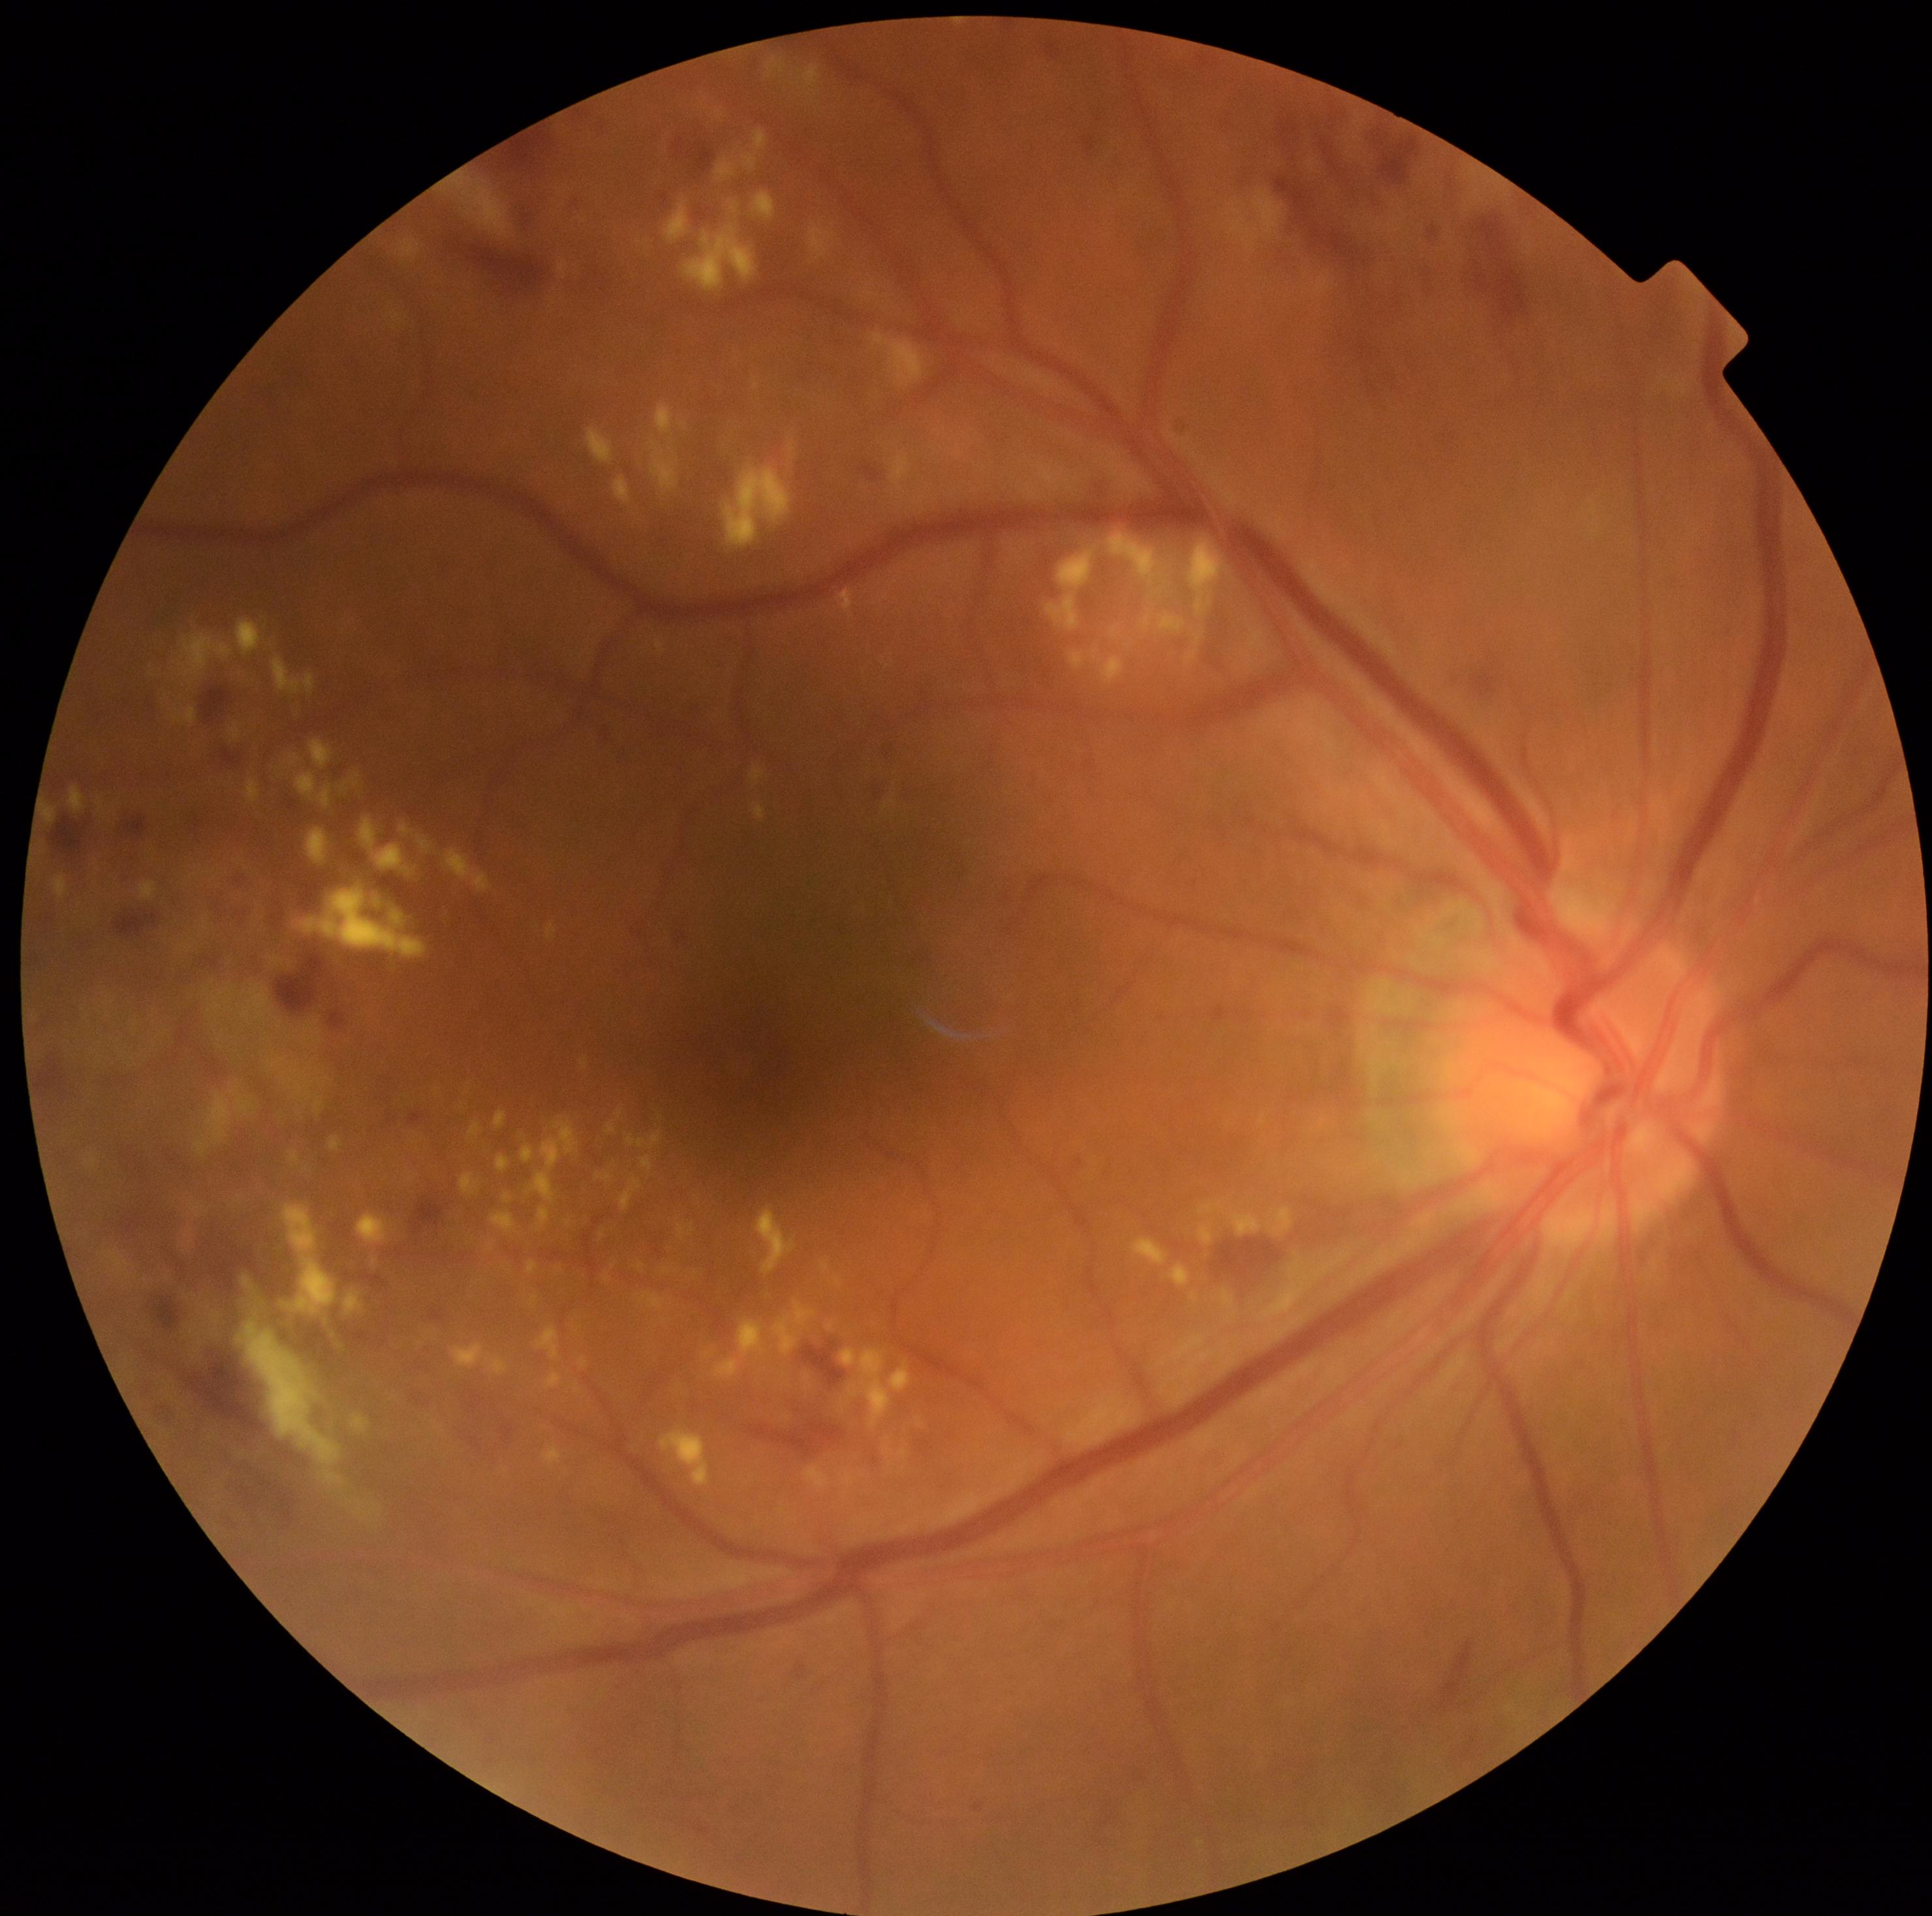

DR stage: grade 2 (moderate NPDR).